Infant wide-field fundus photograph · acquired on the Phoenix ICON · 1240 by 1240 pixels
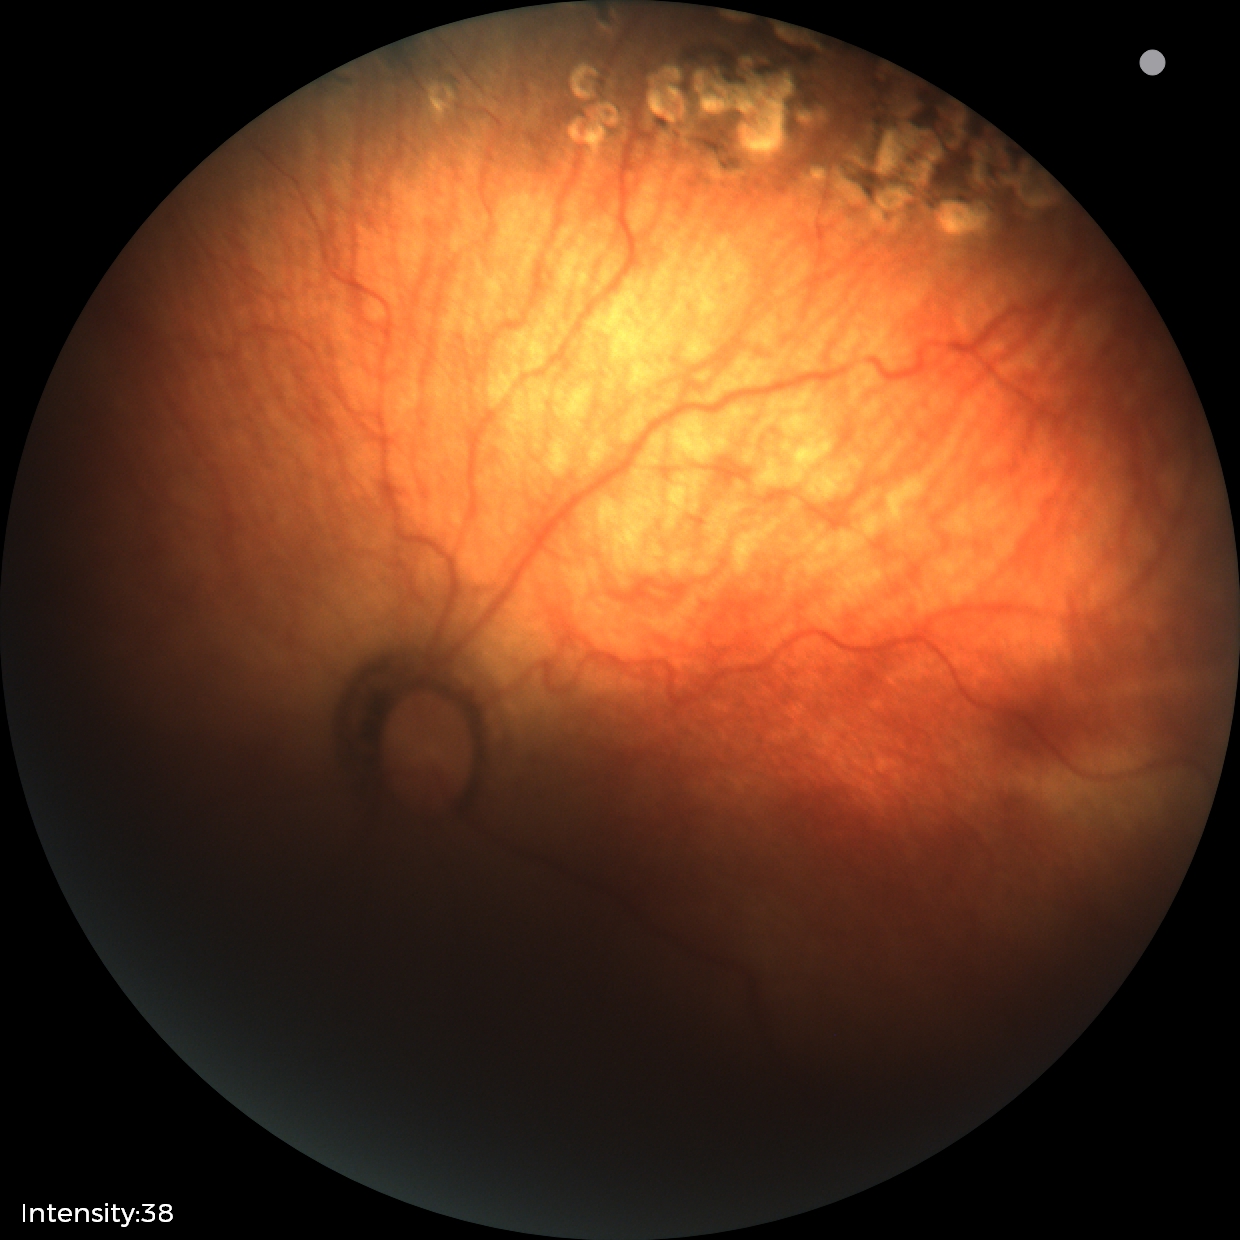

Plus form: absent — posterior pole vessels without abnormal dilation or tortuosity, diagnosis: status post retinopathy of prematurity (ROP) — retinal appearance after treated retinopathy of prematurity.